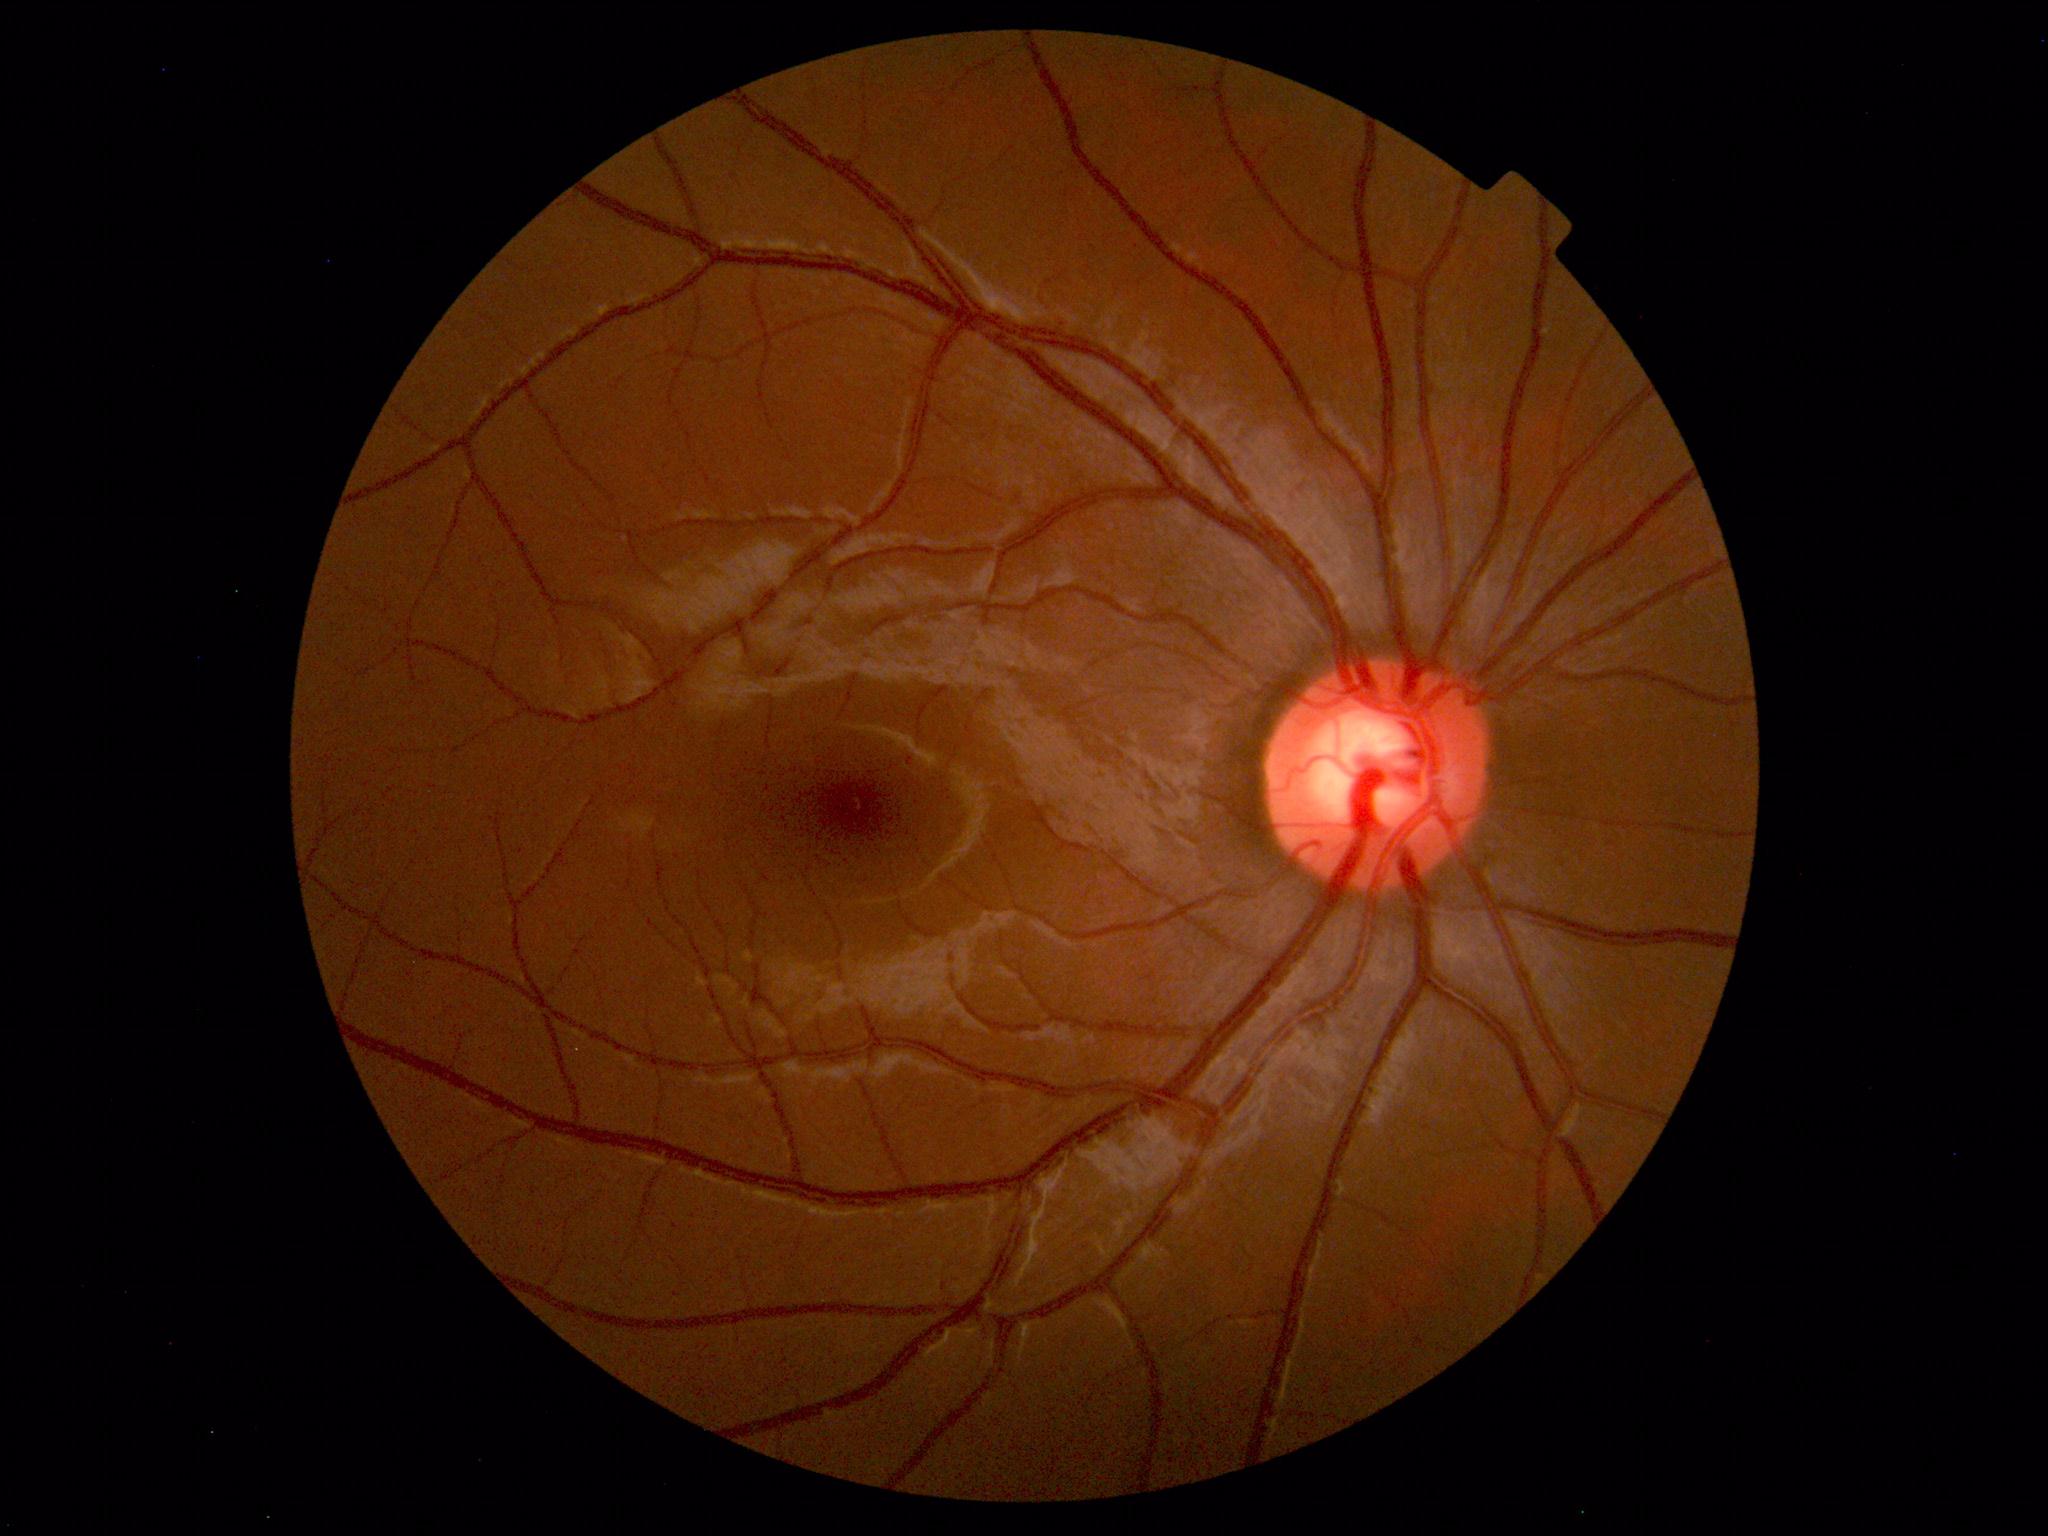
No retinal pathology identified.